Nonmydriatic.
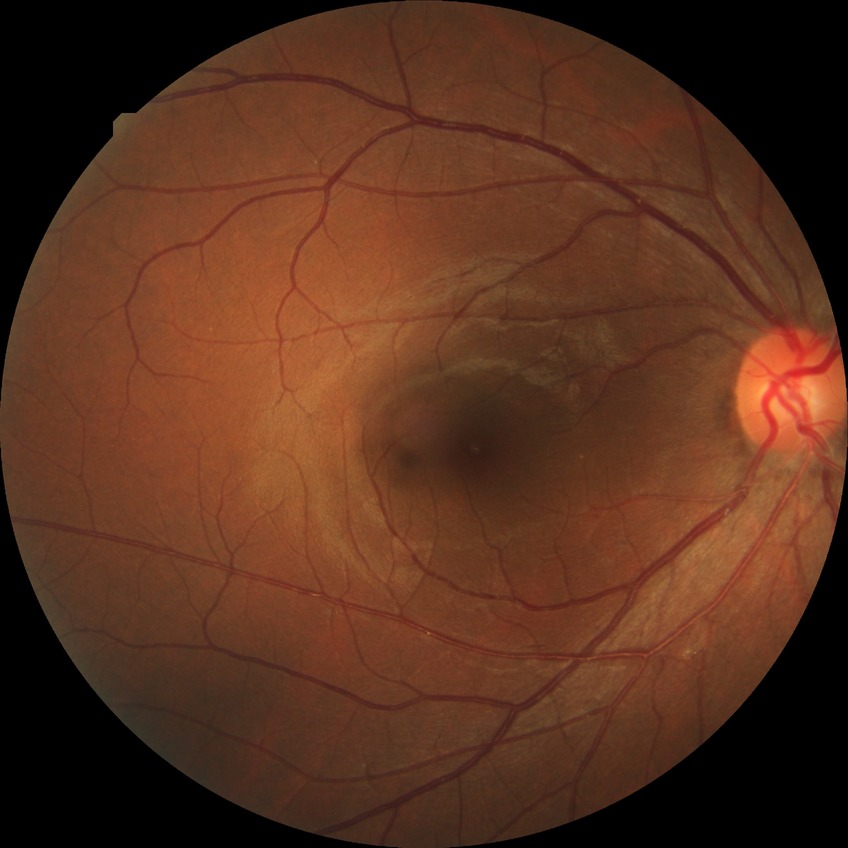
diabetic retinopathy grade: no diabetic retinopathy.